Graded on the modified Davis scale:
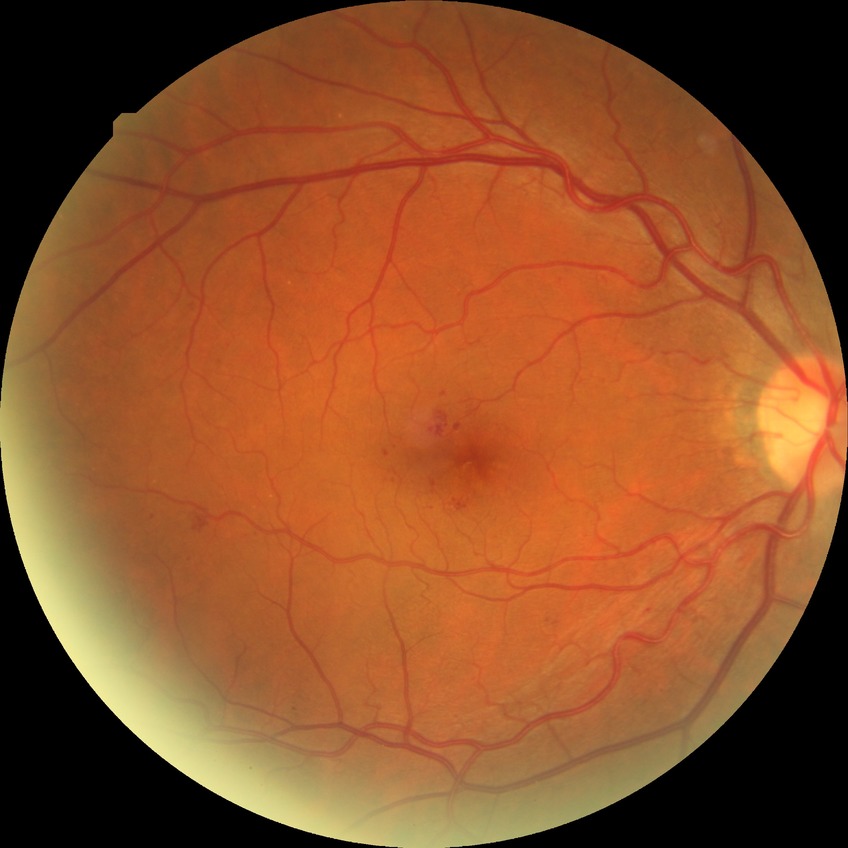
modified Davis grade = SDR.